Color fundus image
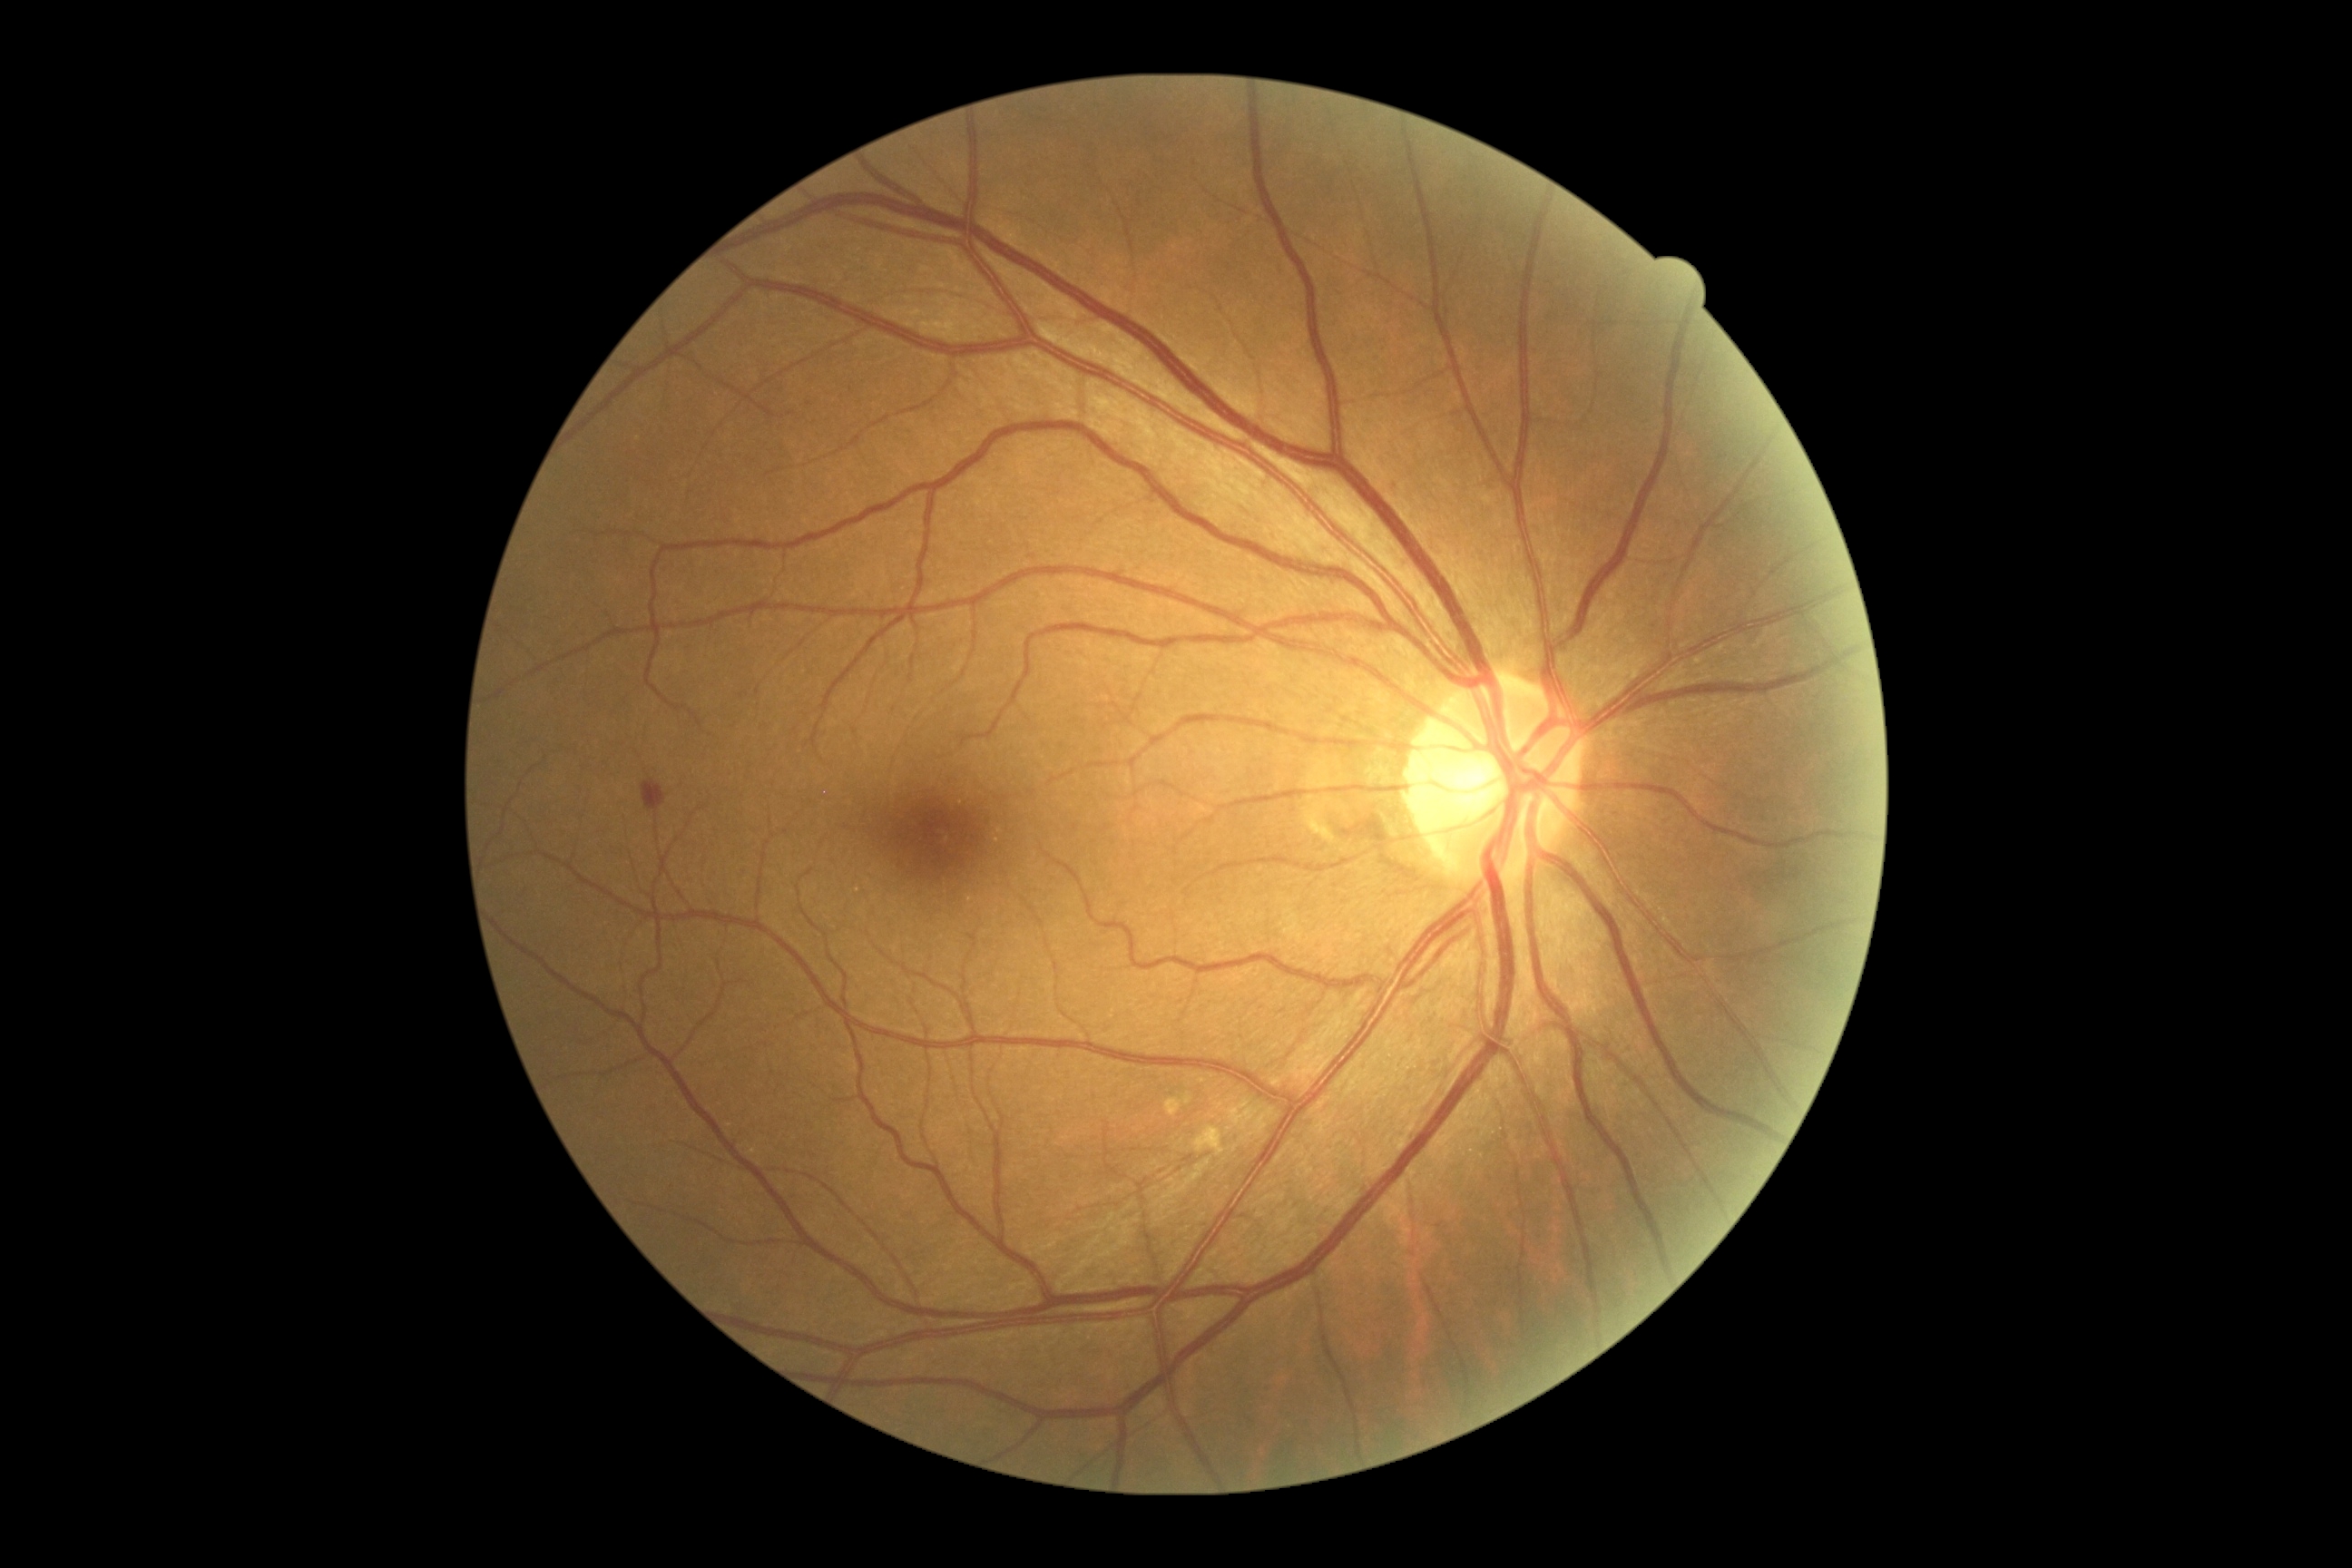

{"dr_grade": 2, "dr_grade_name": "moderate NPDR", "lesions": {"ex": null, "ma": [[1391, 480, 1404, 498]], "se": null, "he": [[642, 779, 667, 812]]}}